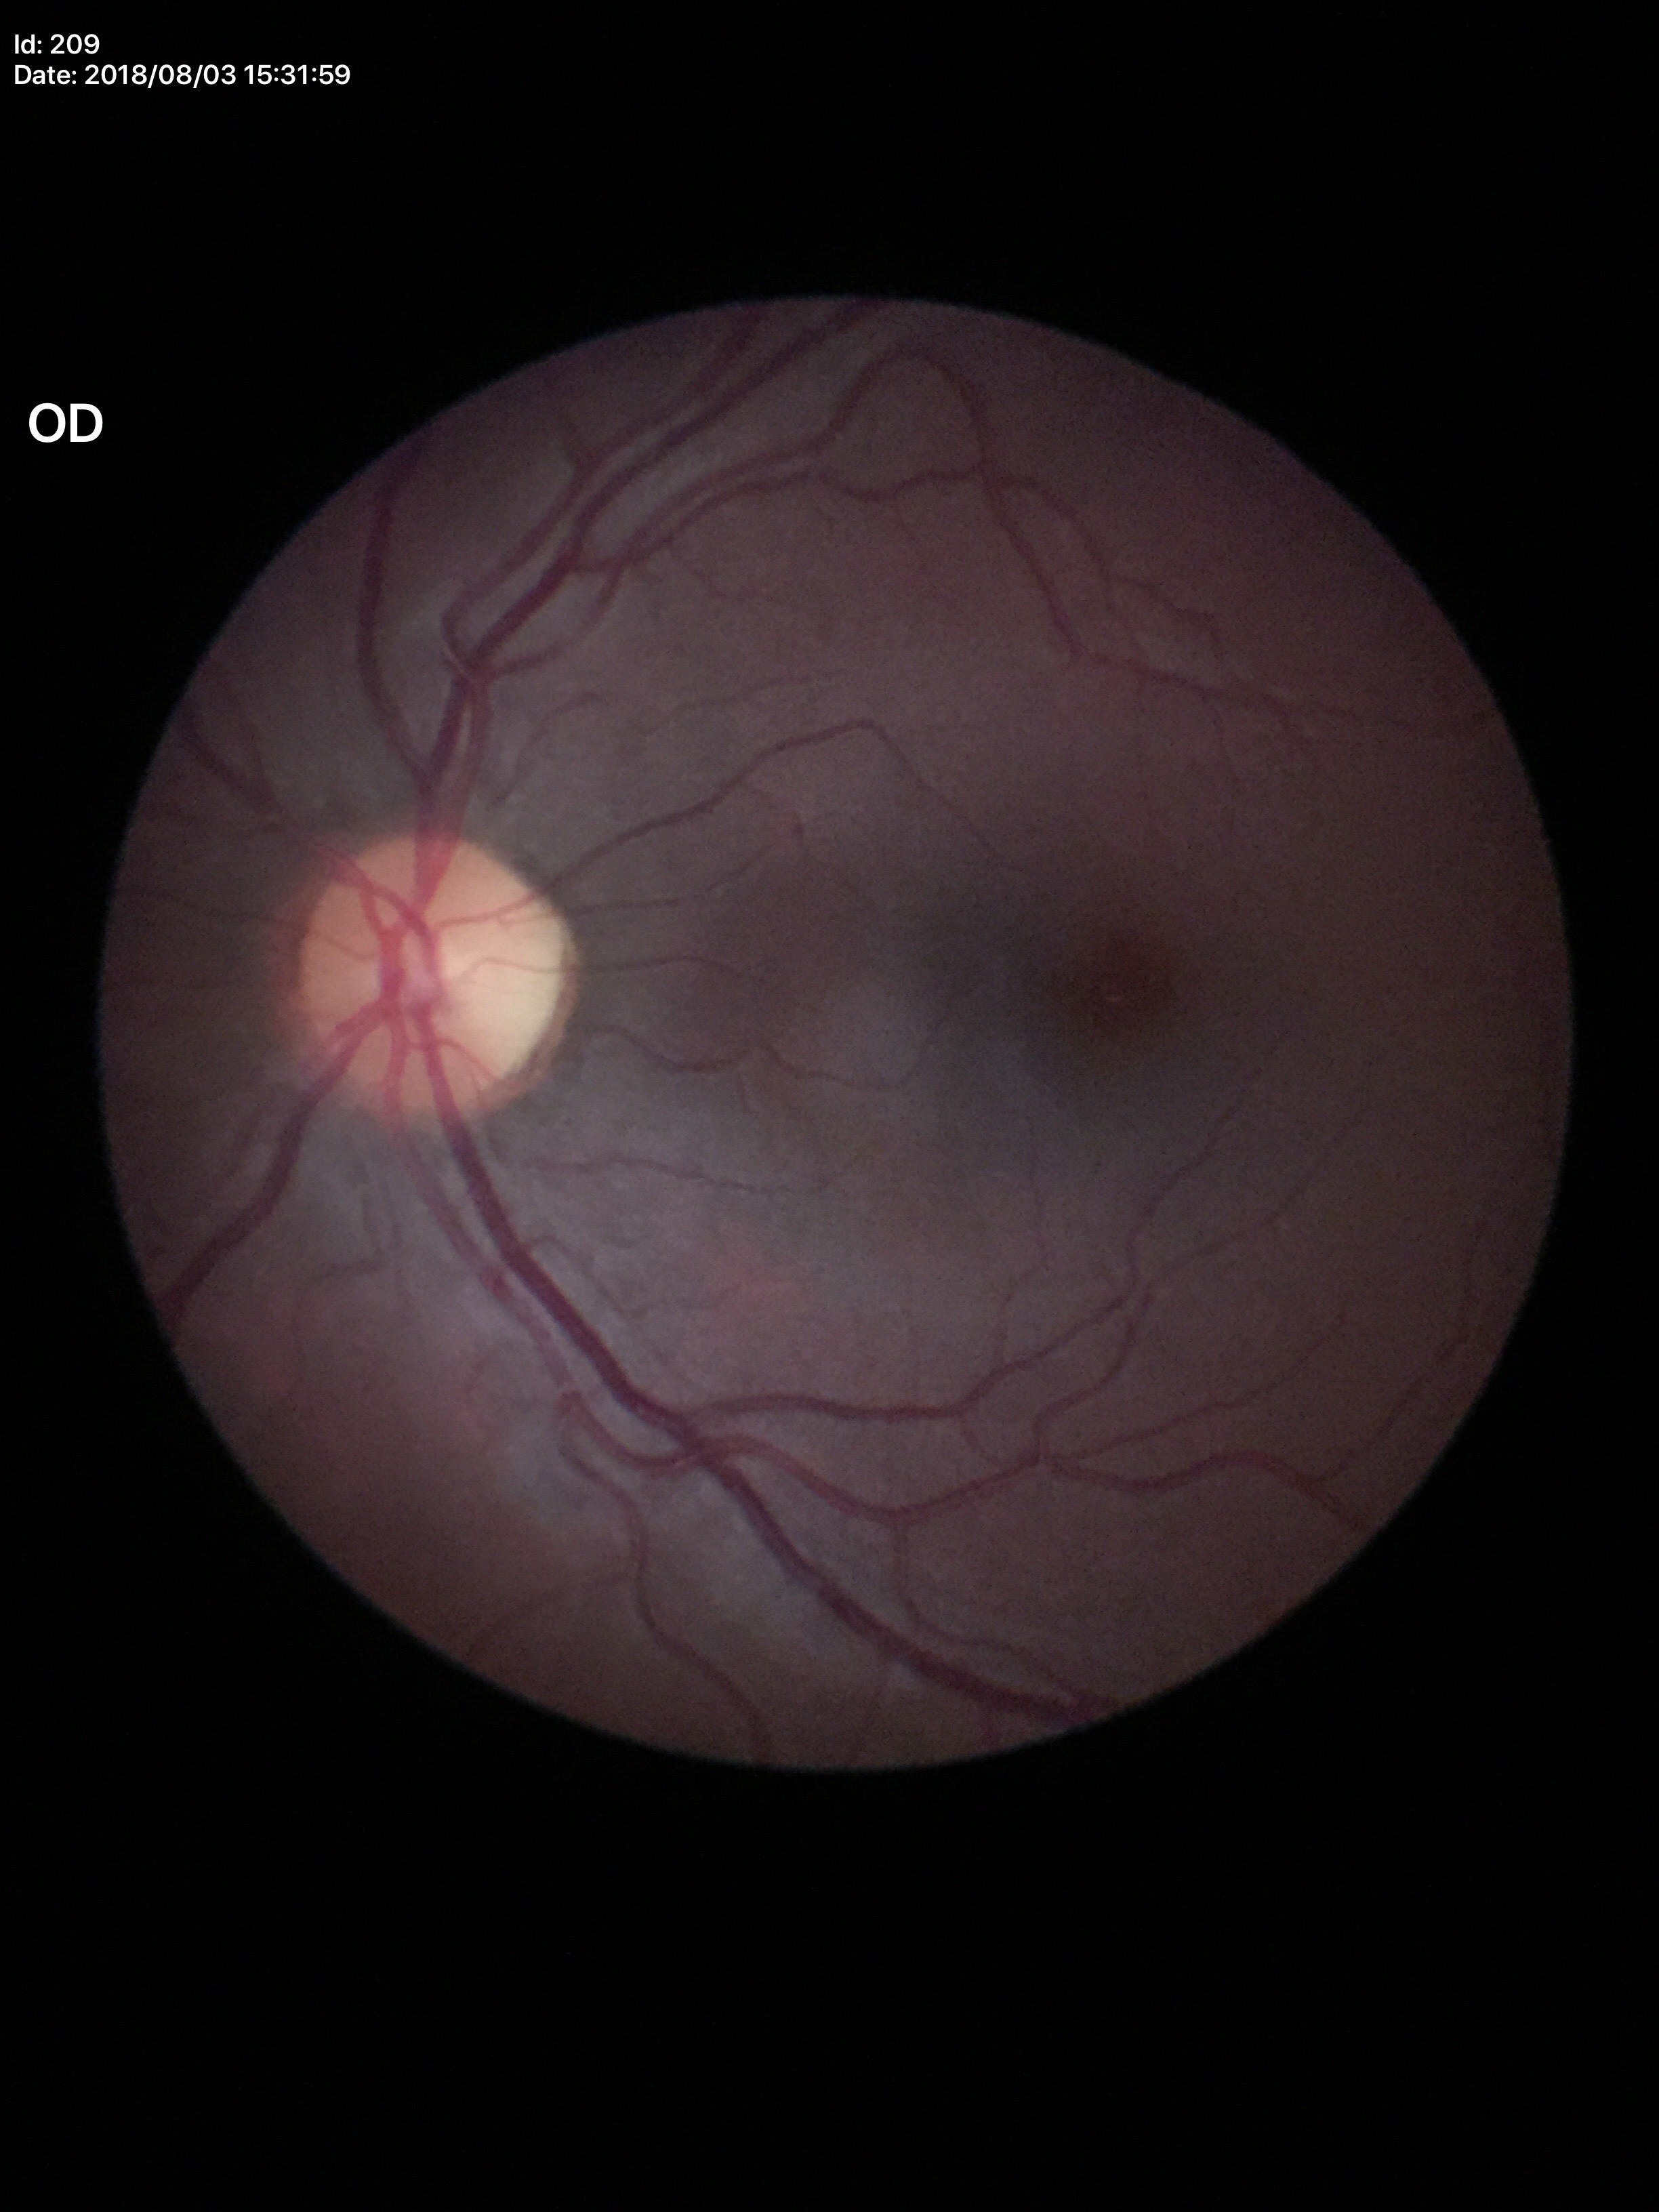

Negative for glaucoma suspicion. Vertical cup-disc ratio is 0.46. Area C/D ratio of 0.21.